No pharmacologic dilation. Image size 848x848.
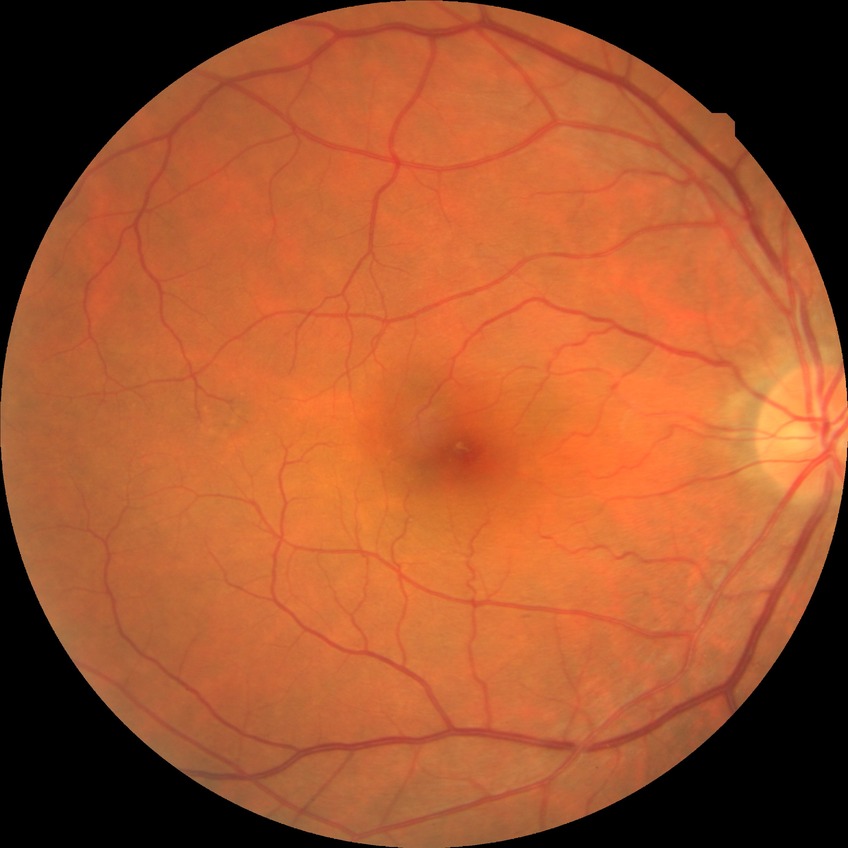
{
  "davis_grade": "NDR (no diabetic retinopathy)"
}